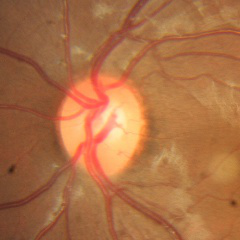

Demonstrates no glaucomatous optic neuropathy.